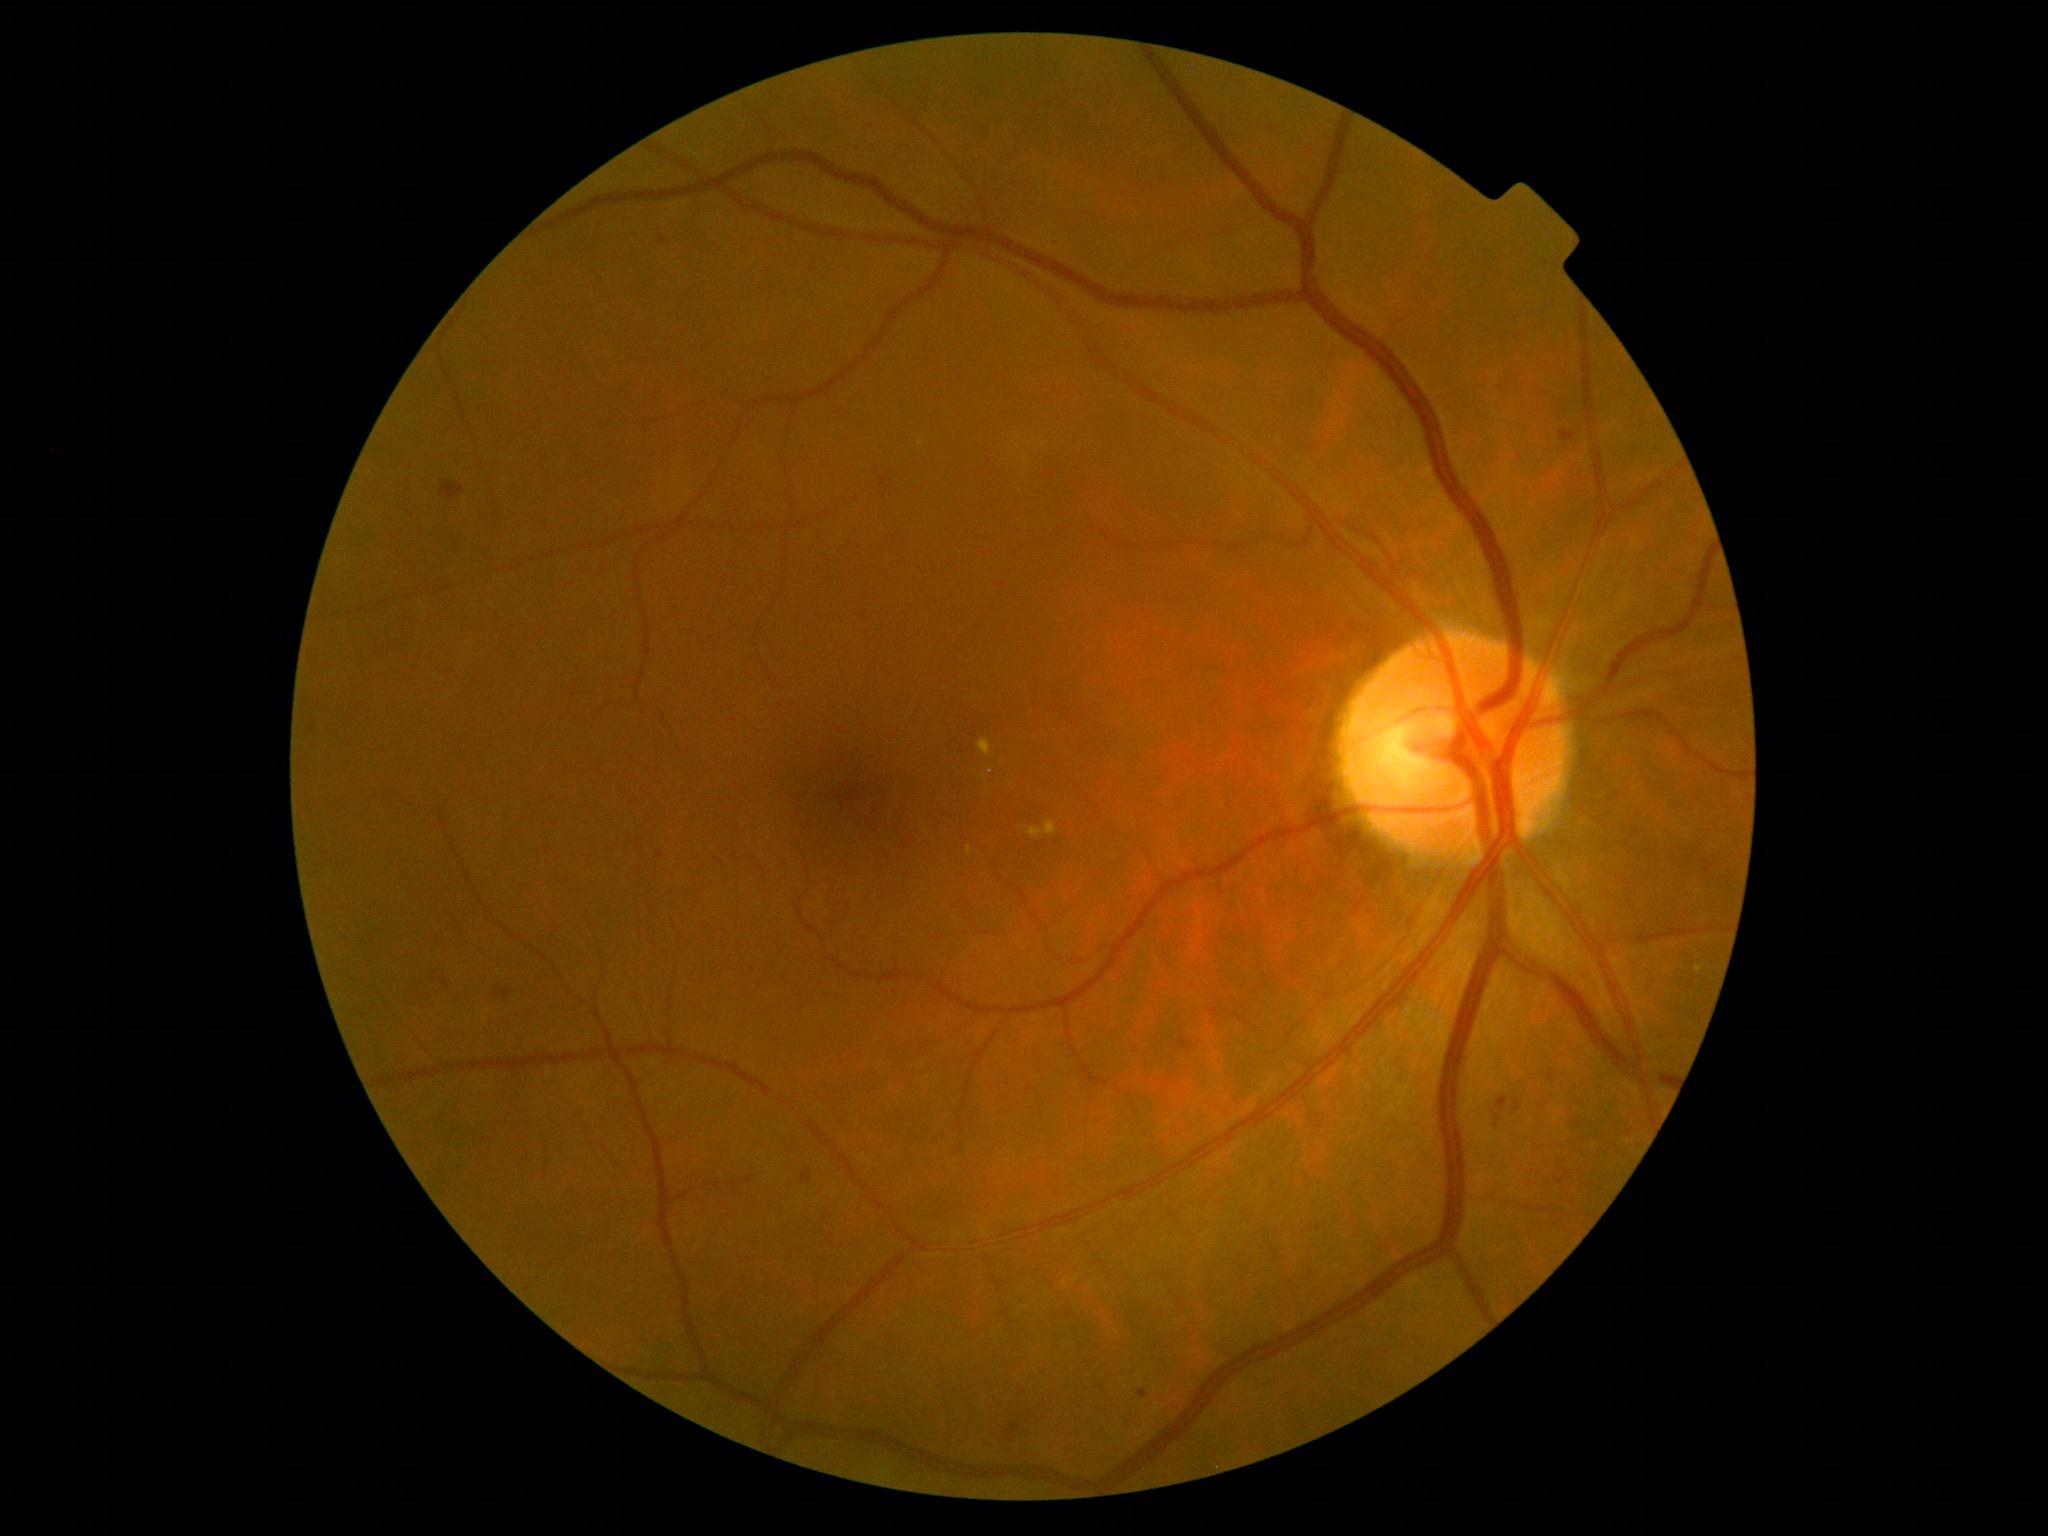

DR severity = grade 2.